Wide-field fundus photograph from neonatal ROP screening. 640 x 480 pixels — 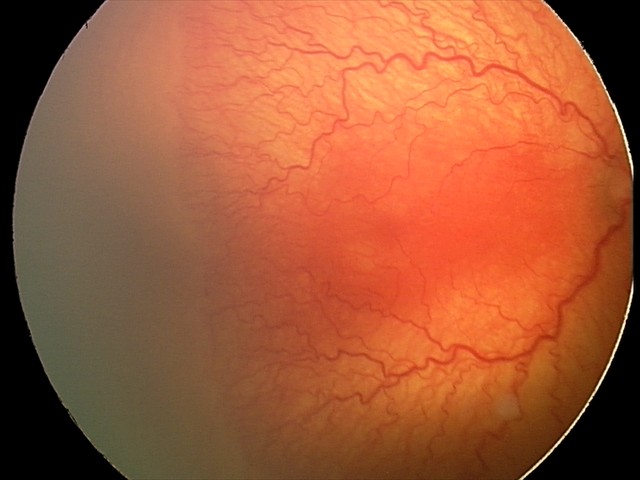
Plus disease = present, assessment = aggressive retinopathy of prematurity (A-ROP).